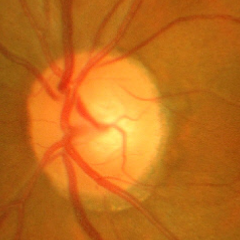
The image shows advanced-stage glaucoma.